Modified Davis classification; FOV: 45 degrees.
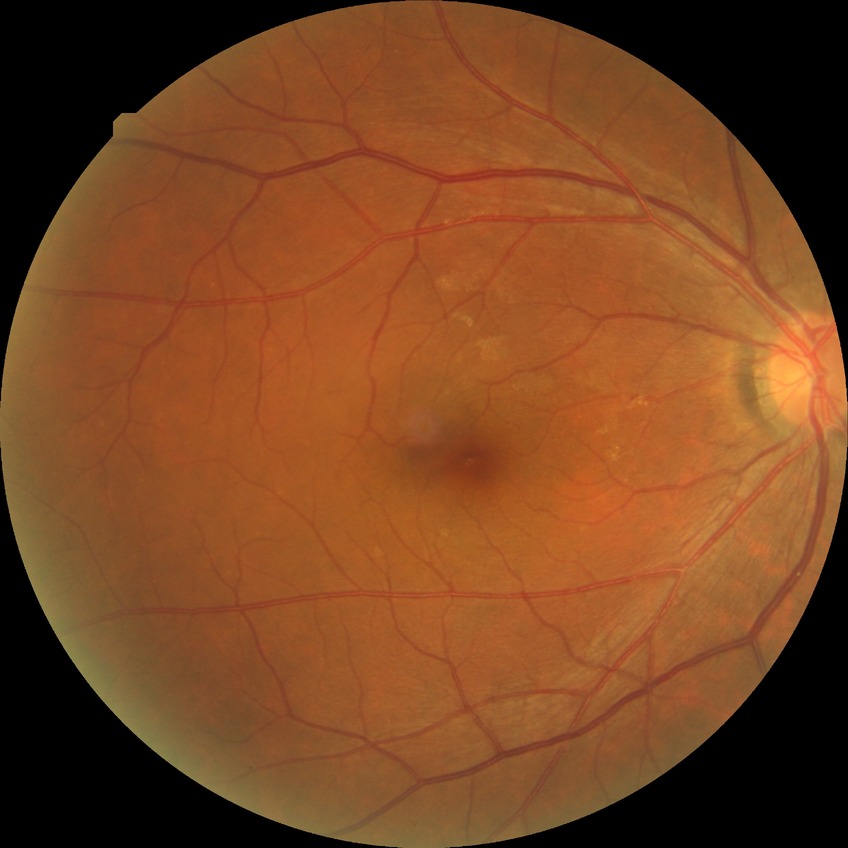

Assessment:
– DR — NDR